Retinal fundus photograph
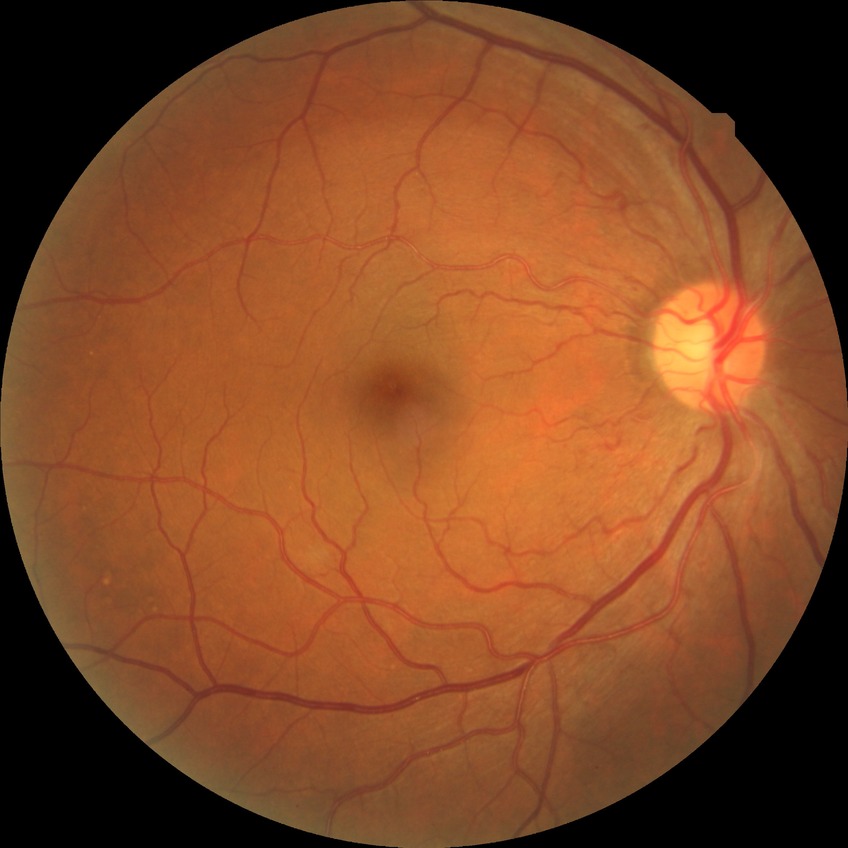 DR stage: NDR.